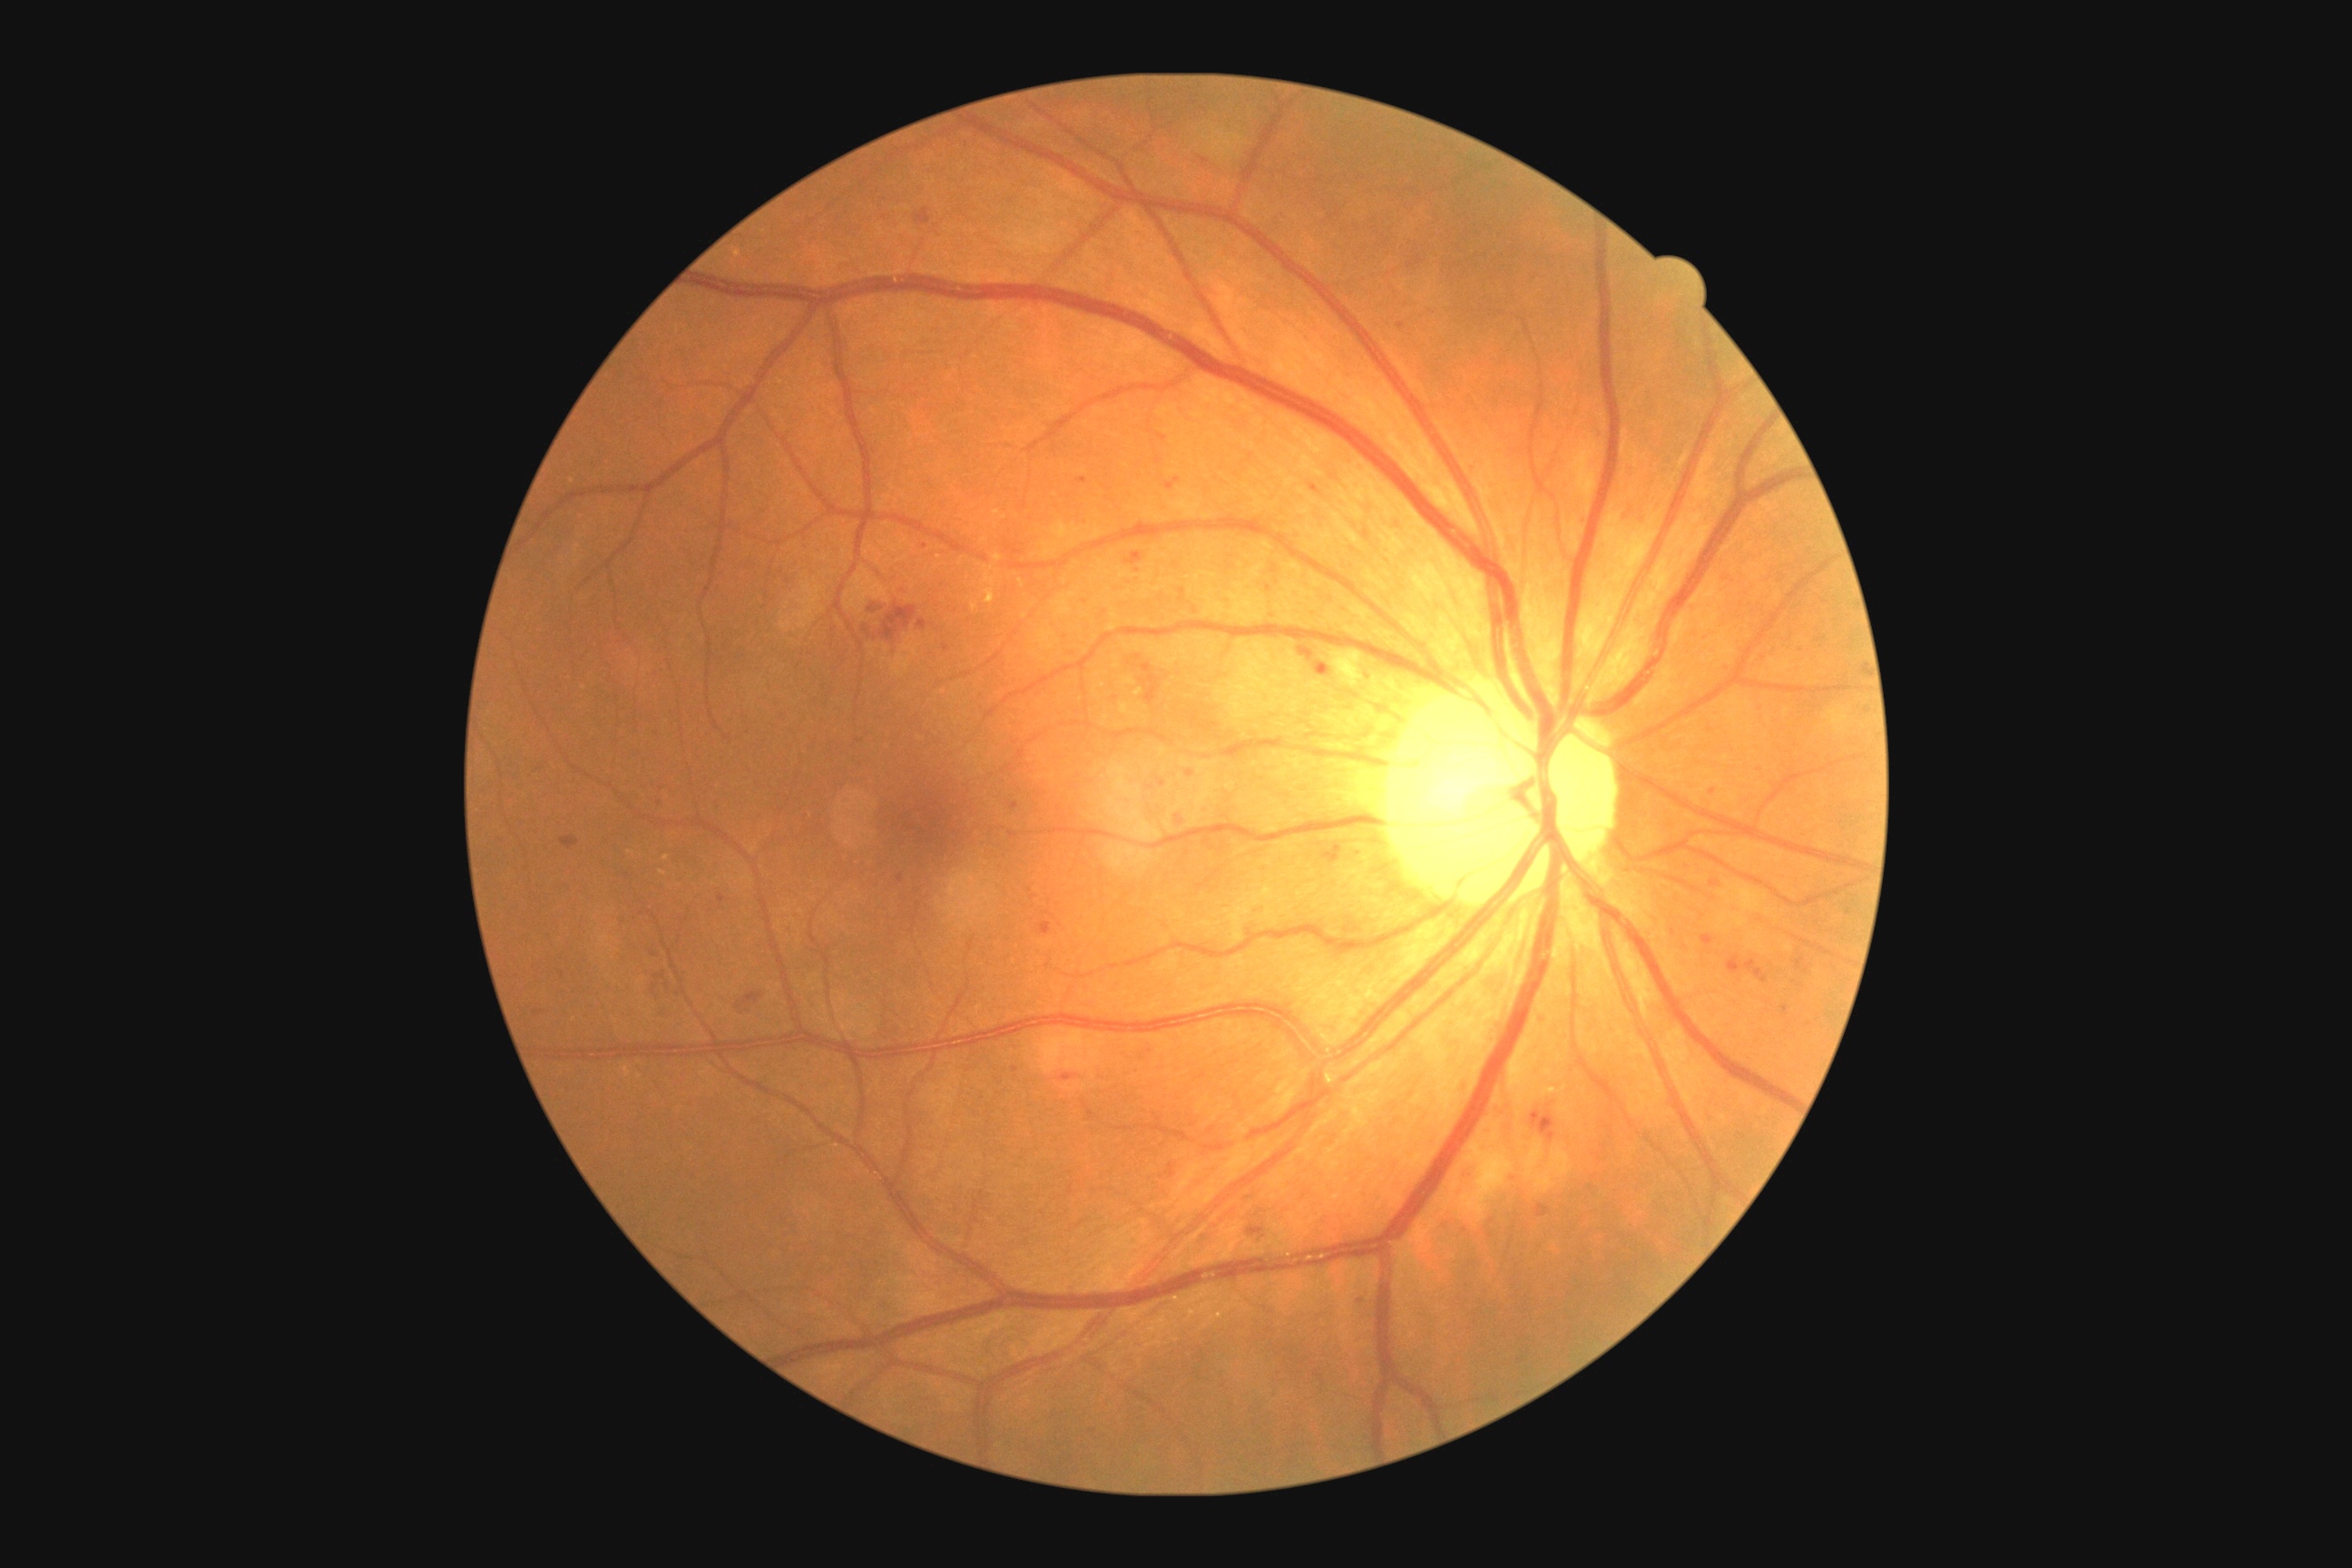
Annotations:
* diabetic retinopathy grade — 2